Retinal fundus photograph — 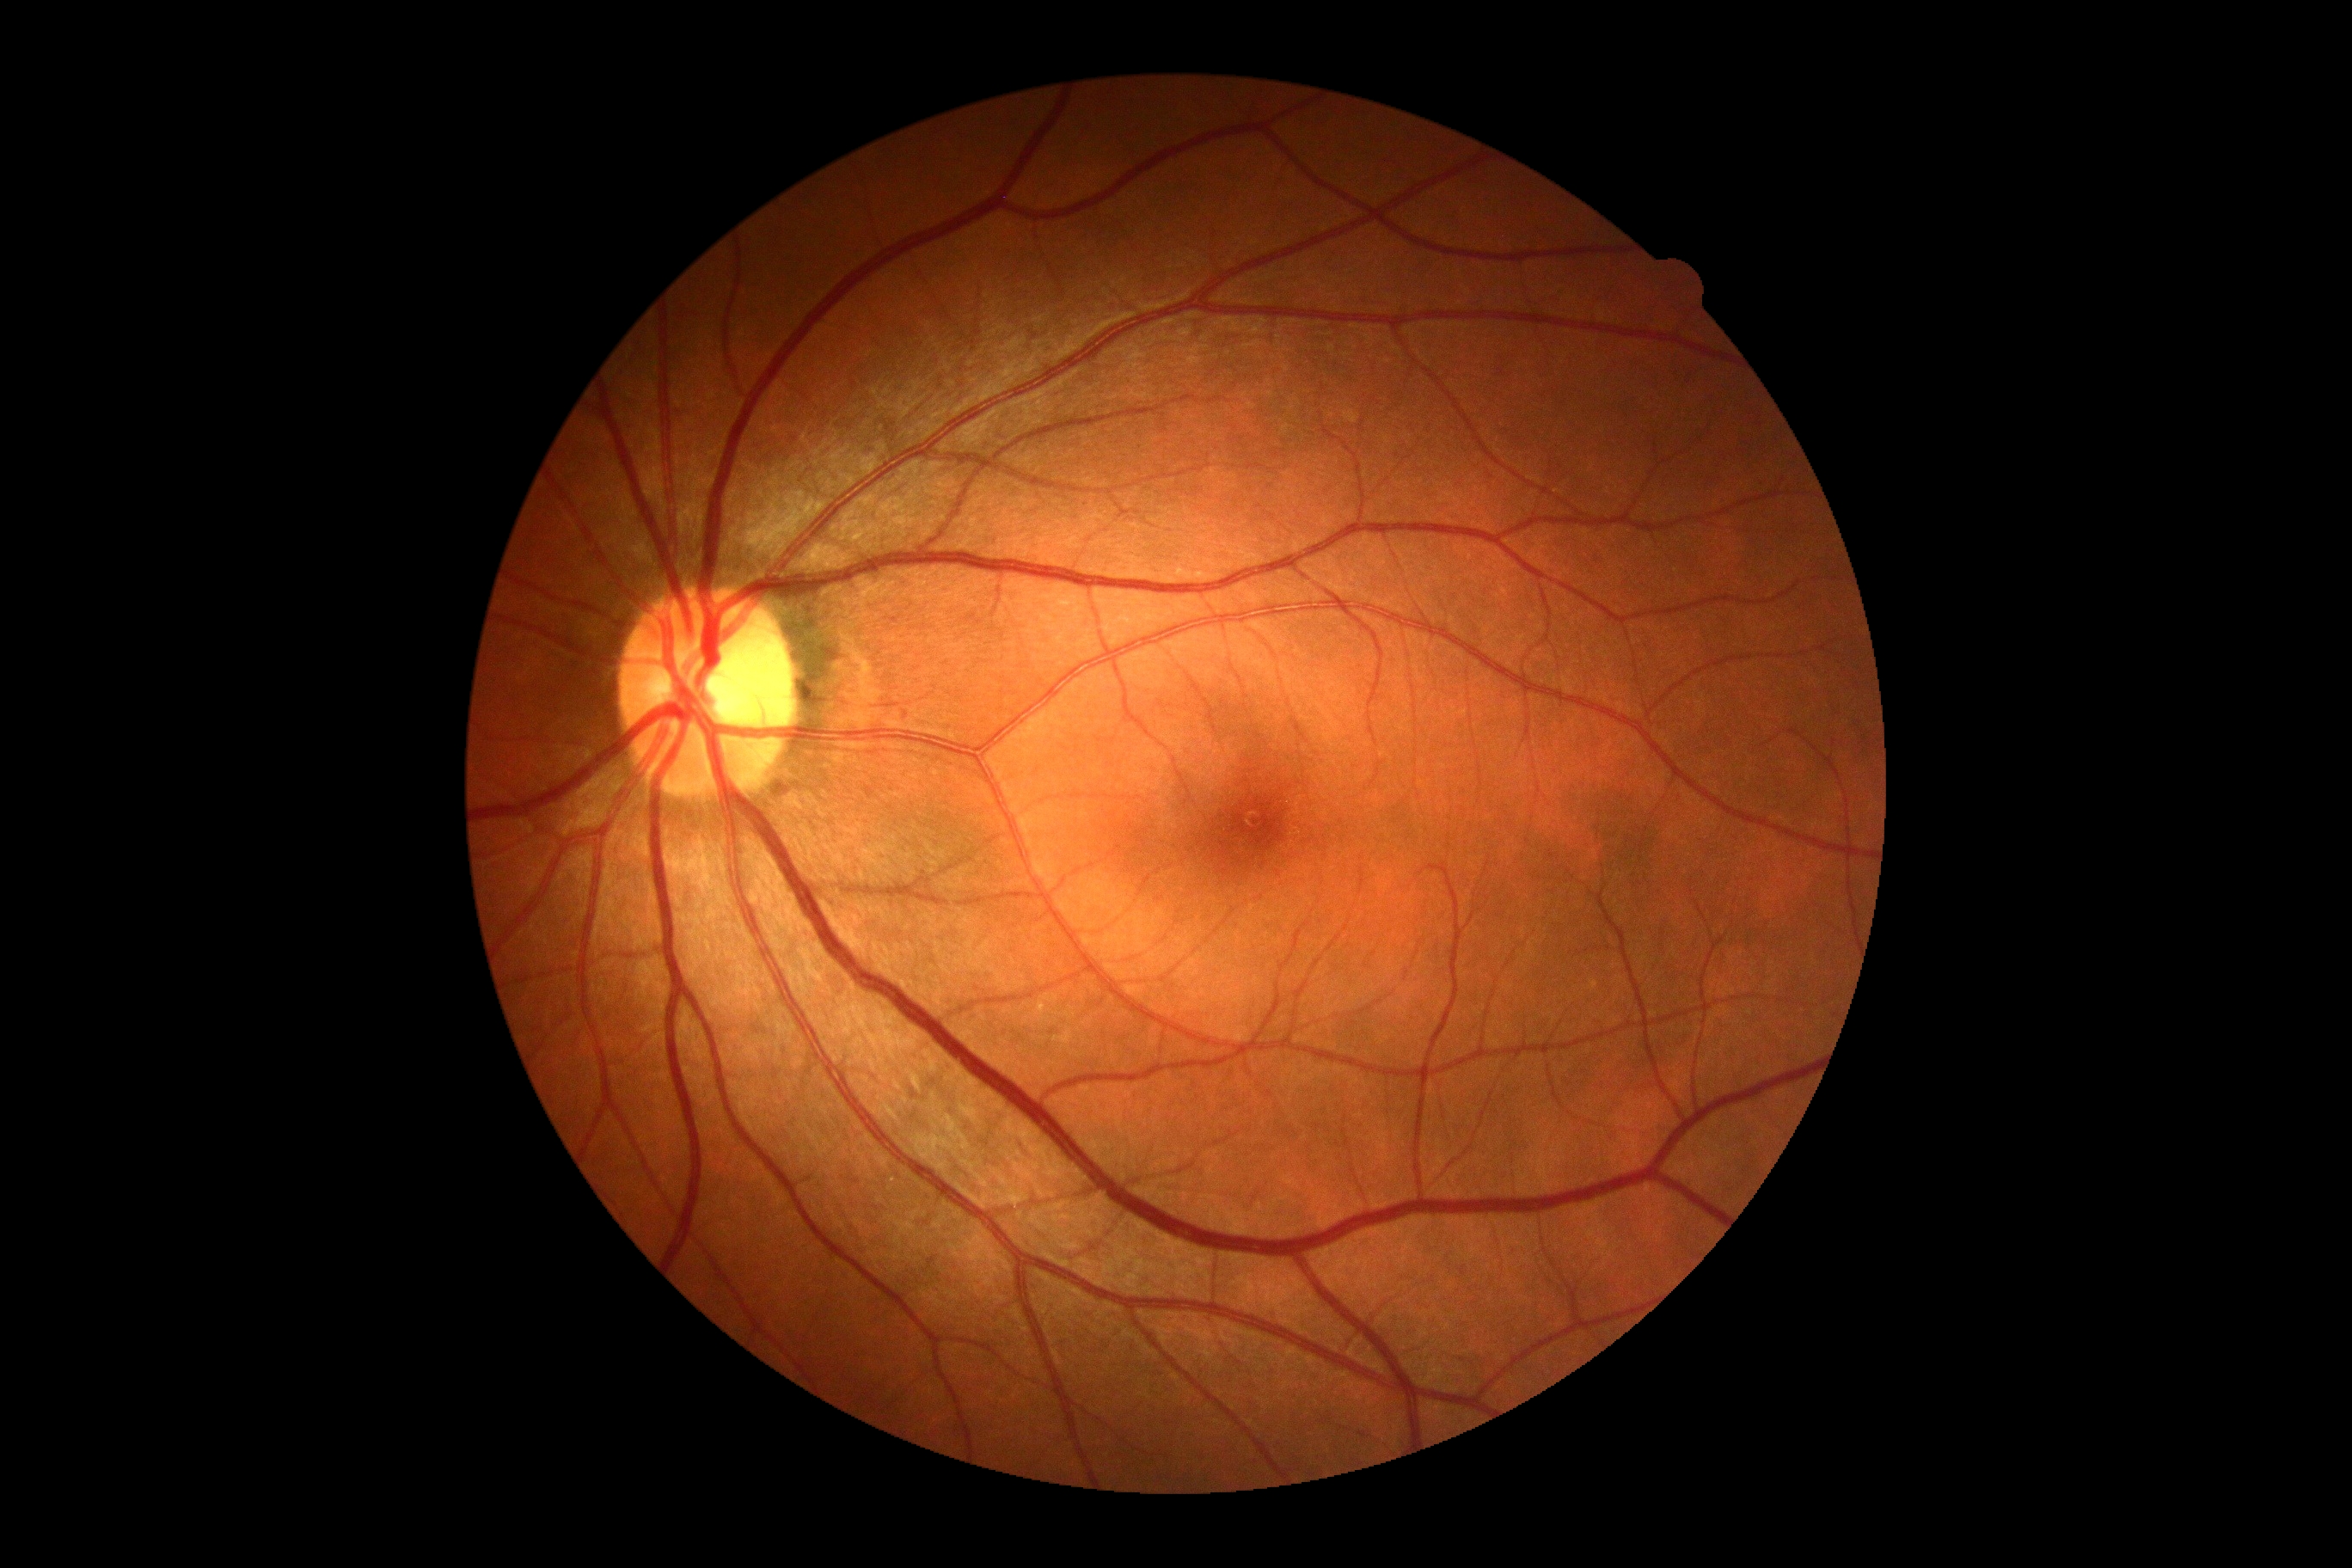

No apparent diabetic retinopathy.
Diabetic retinopathy severity is grade 0 (no apparent retinopathy).